Color fundus photograph, 512 x 512 pixels: 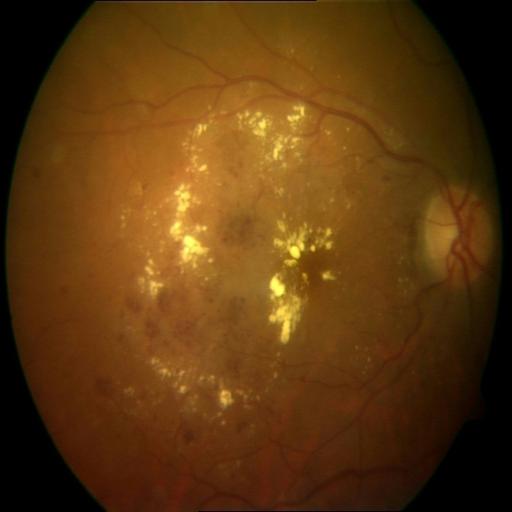
Demonstrates cystoid macular edema, hemorrhagic retinopathy, and exudation.